Image size 2212x1659
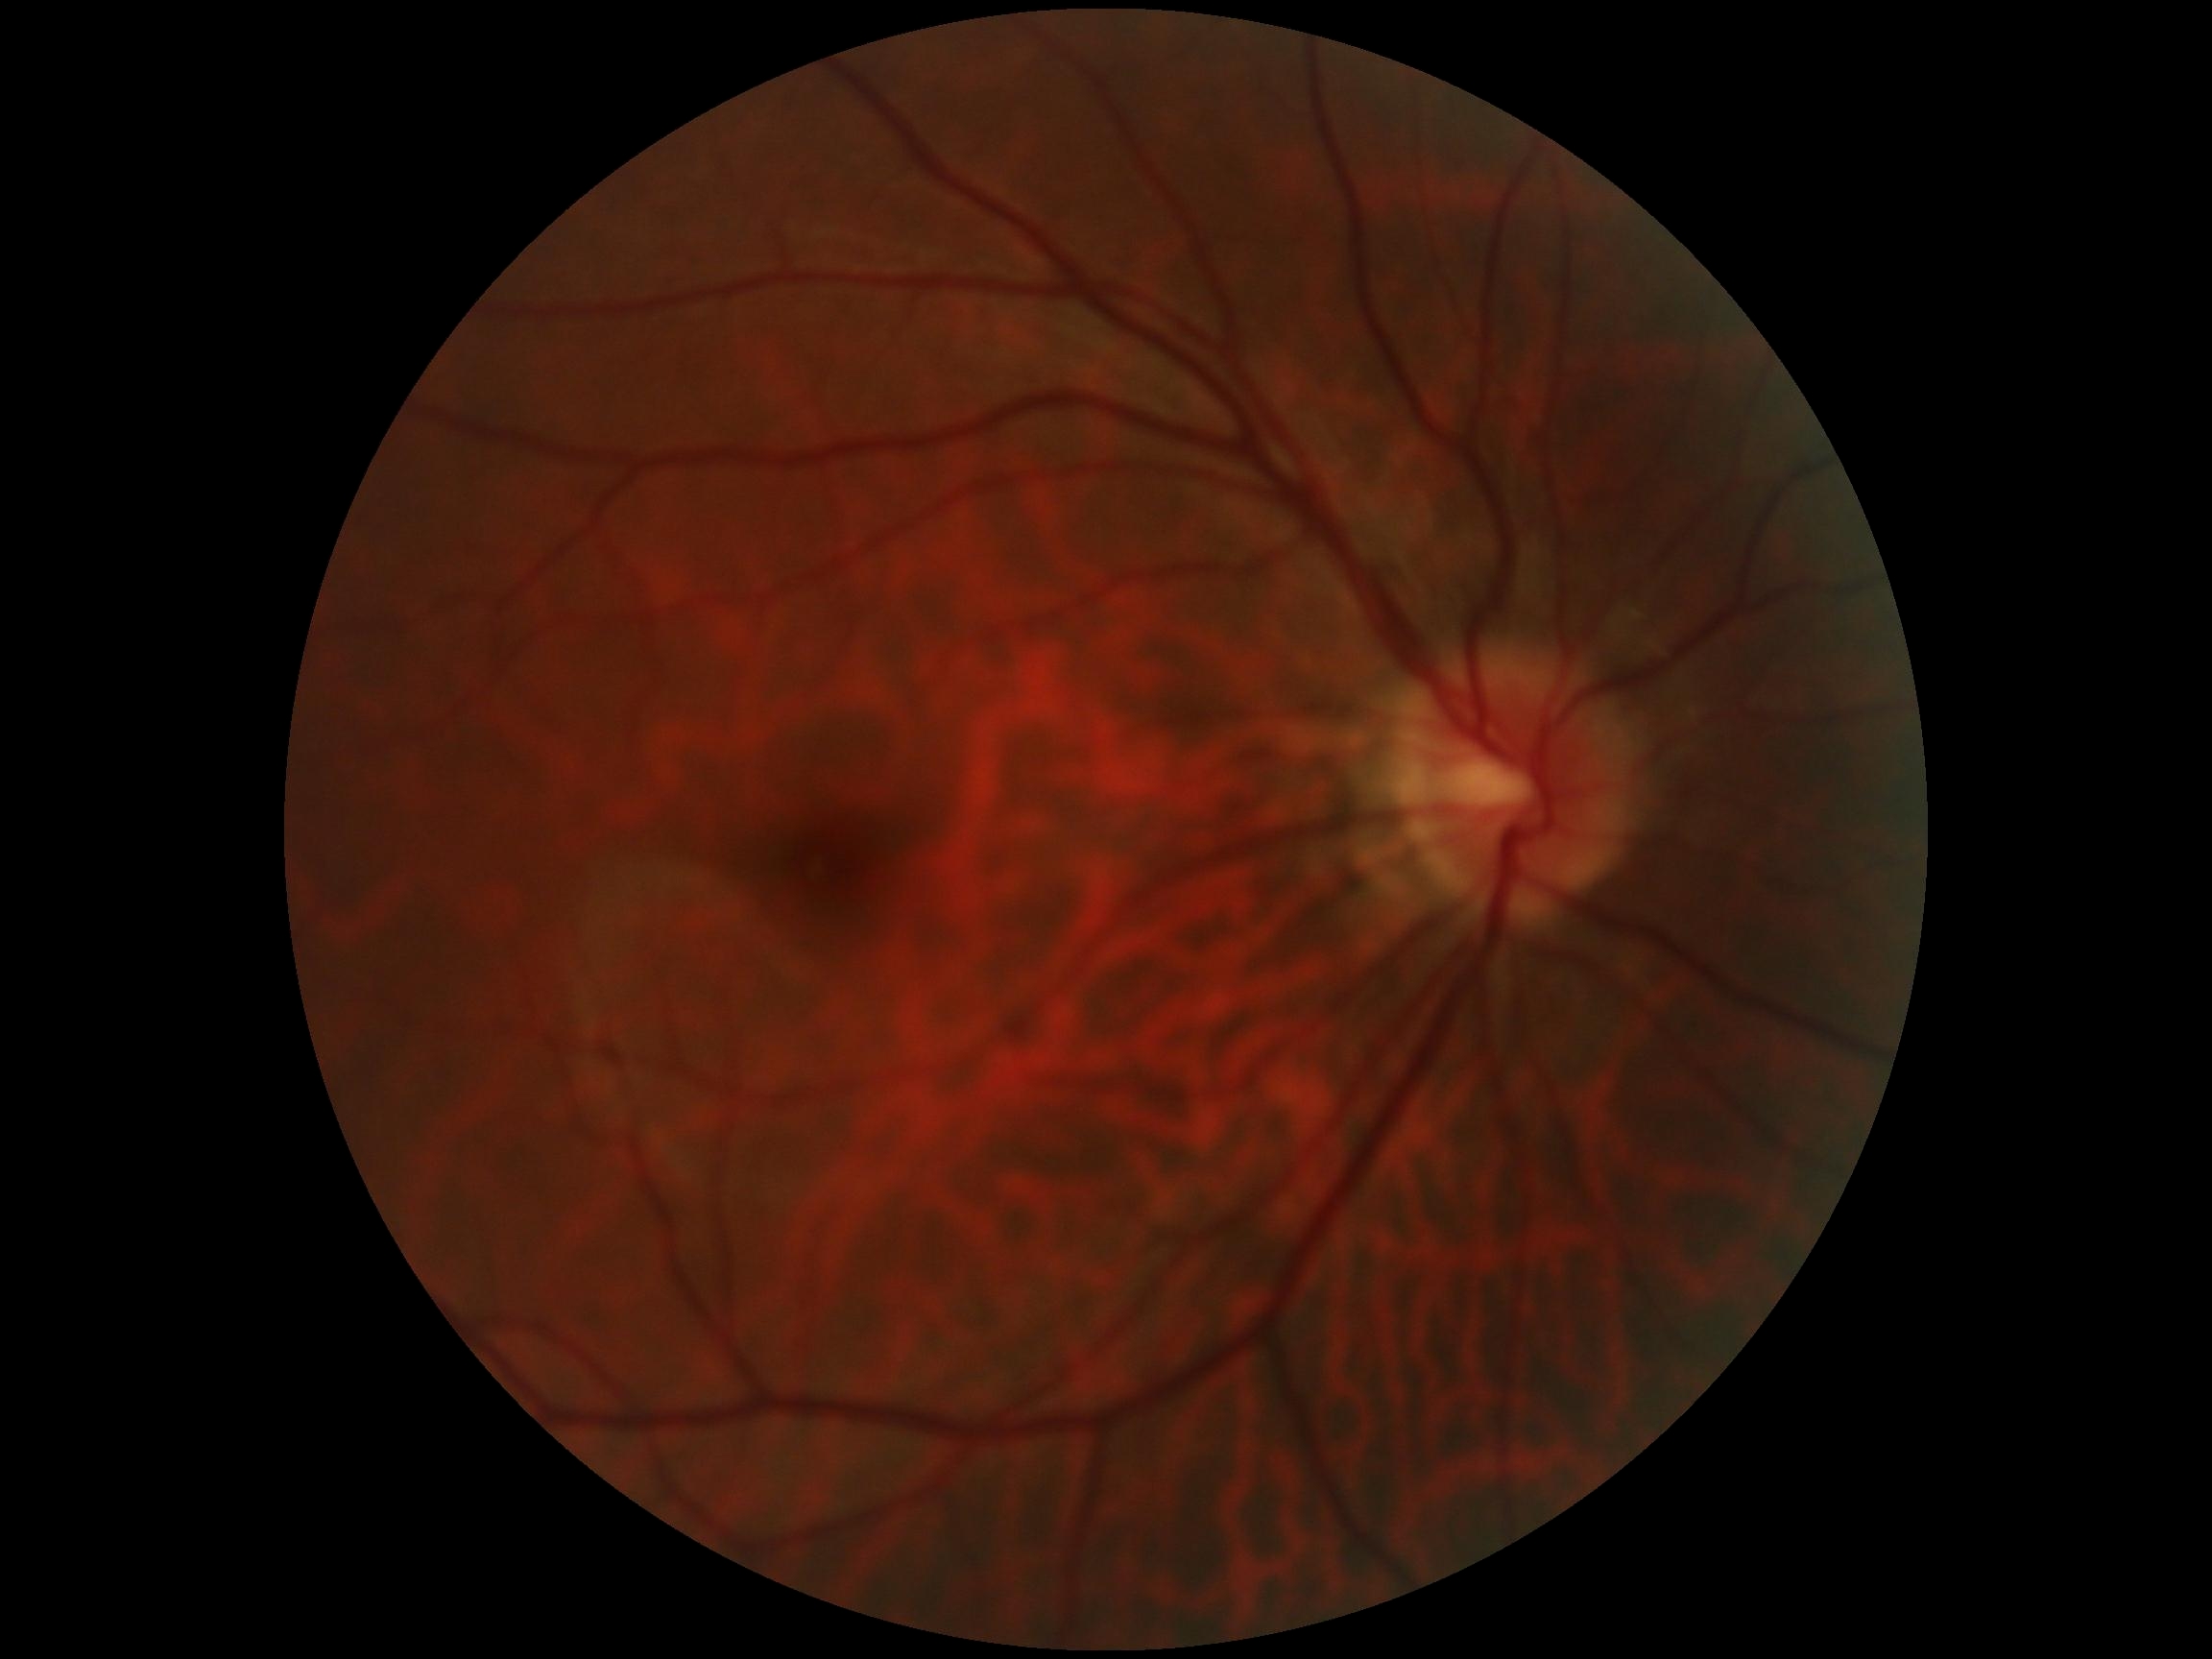 DR grade: 0 (no apparent retinopathy) — no visible signs of diabetic retinopathy.